Modified Davis classification — 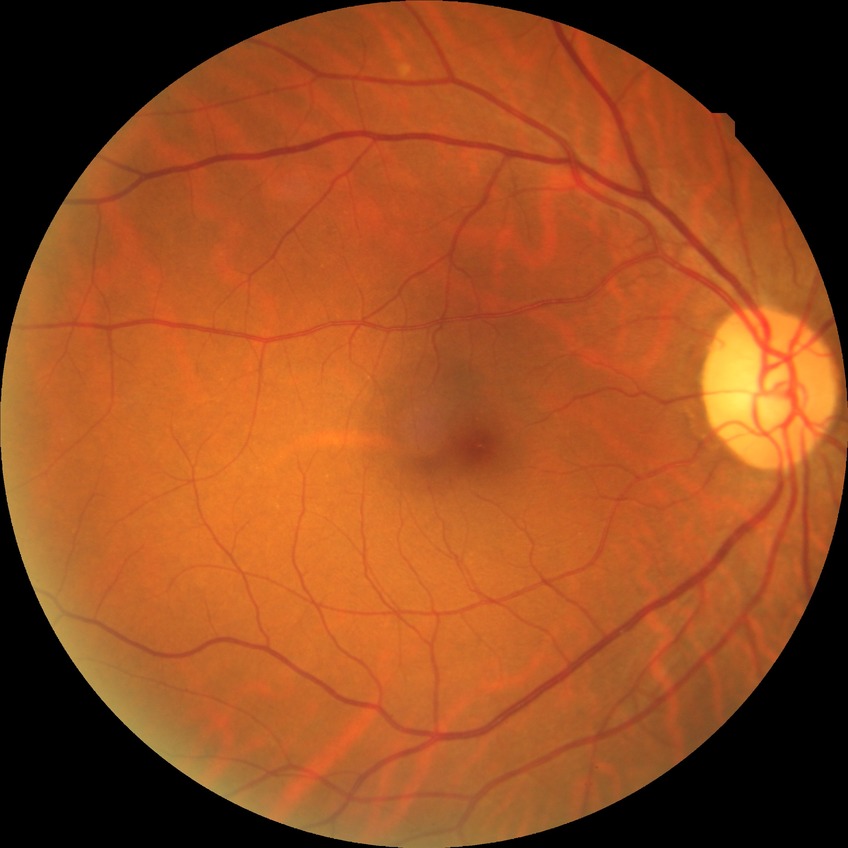
diabetic retinopathy (DR): NDR (no diabetic retinopathy)